Modified Davis classification; CFP
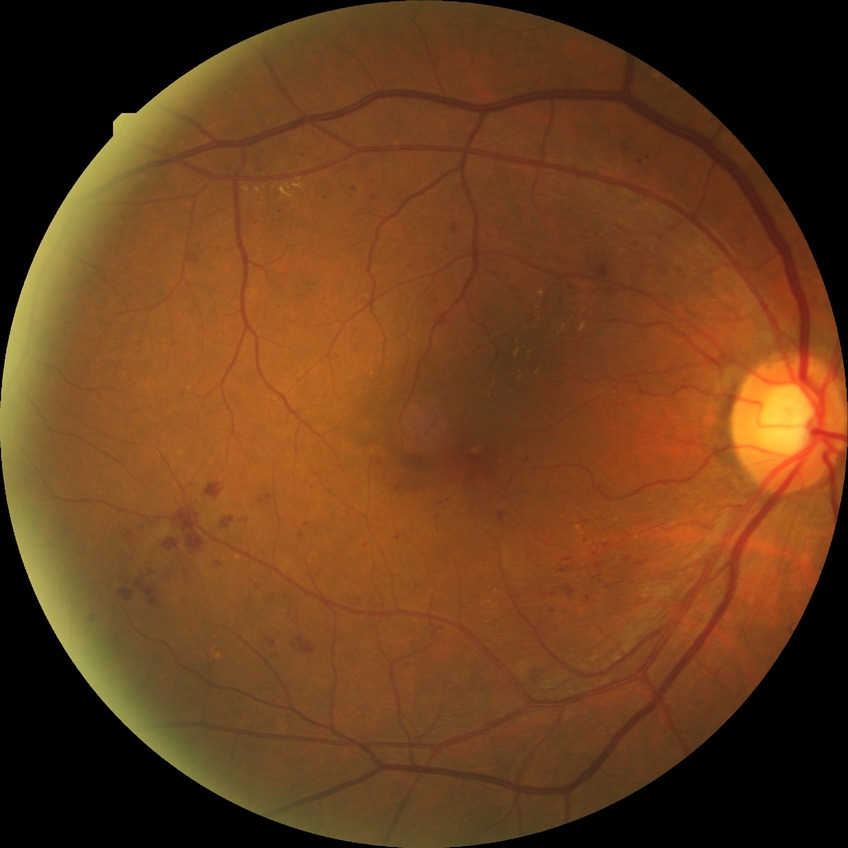

Diabetic retinopathy (DR): simple diabetic retinopathy (SDR).